1725x1721px · 45° field of view: 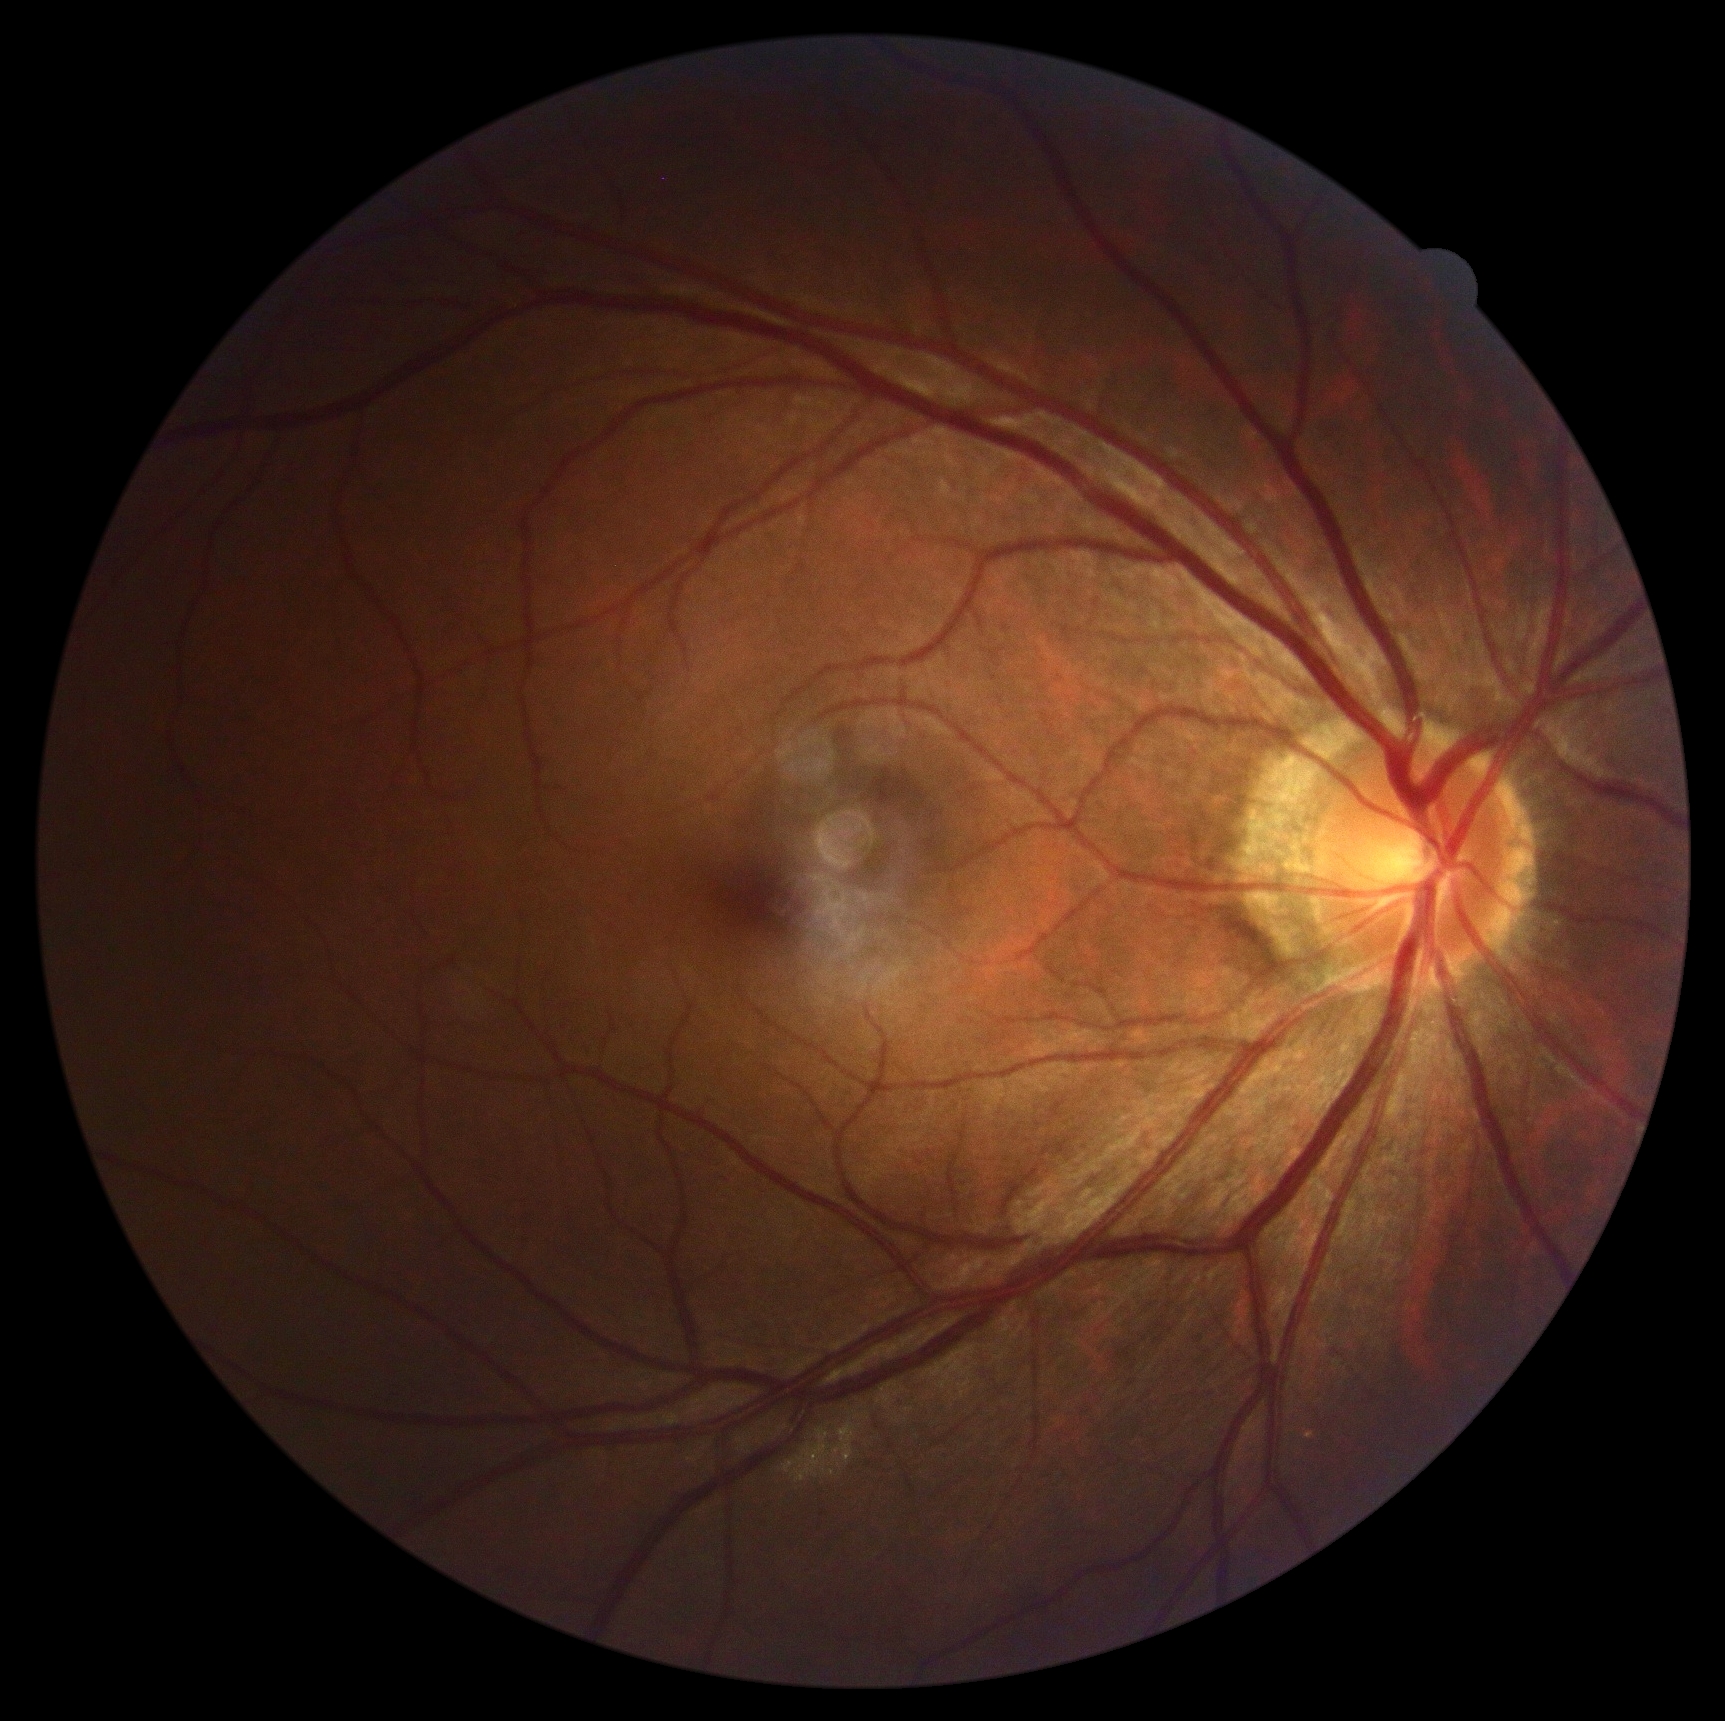 Annotations:
- DR severity: grade 0 (no apparent retinopathy) — no visible signs of diabetic retinopathy